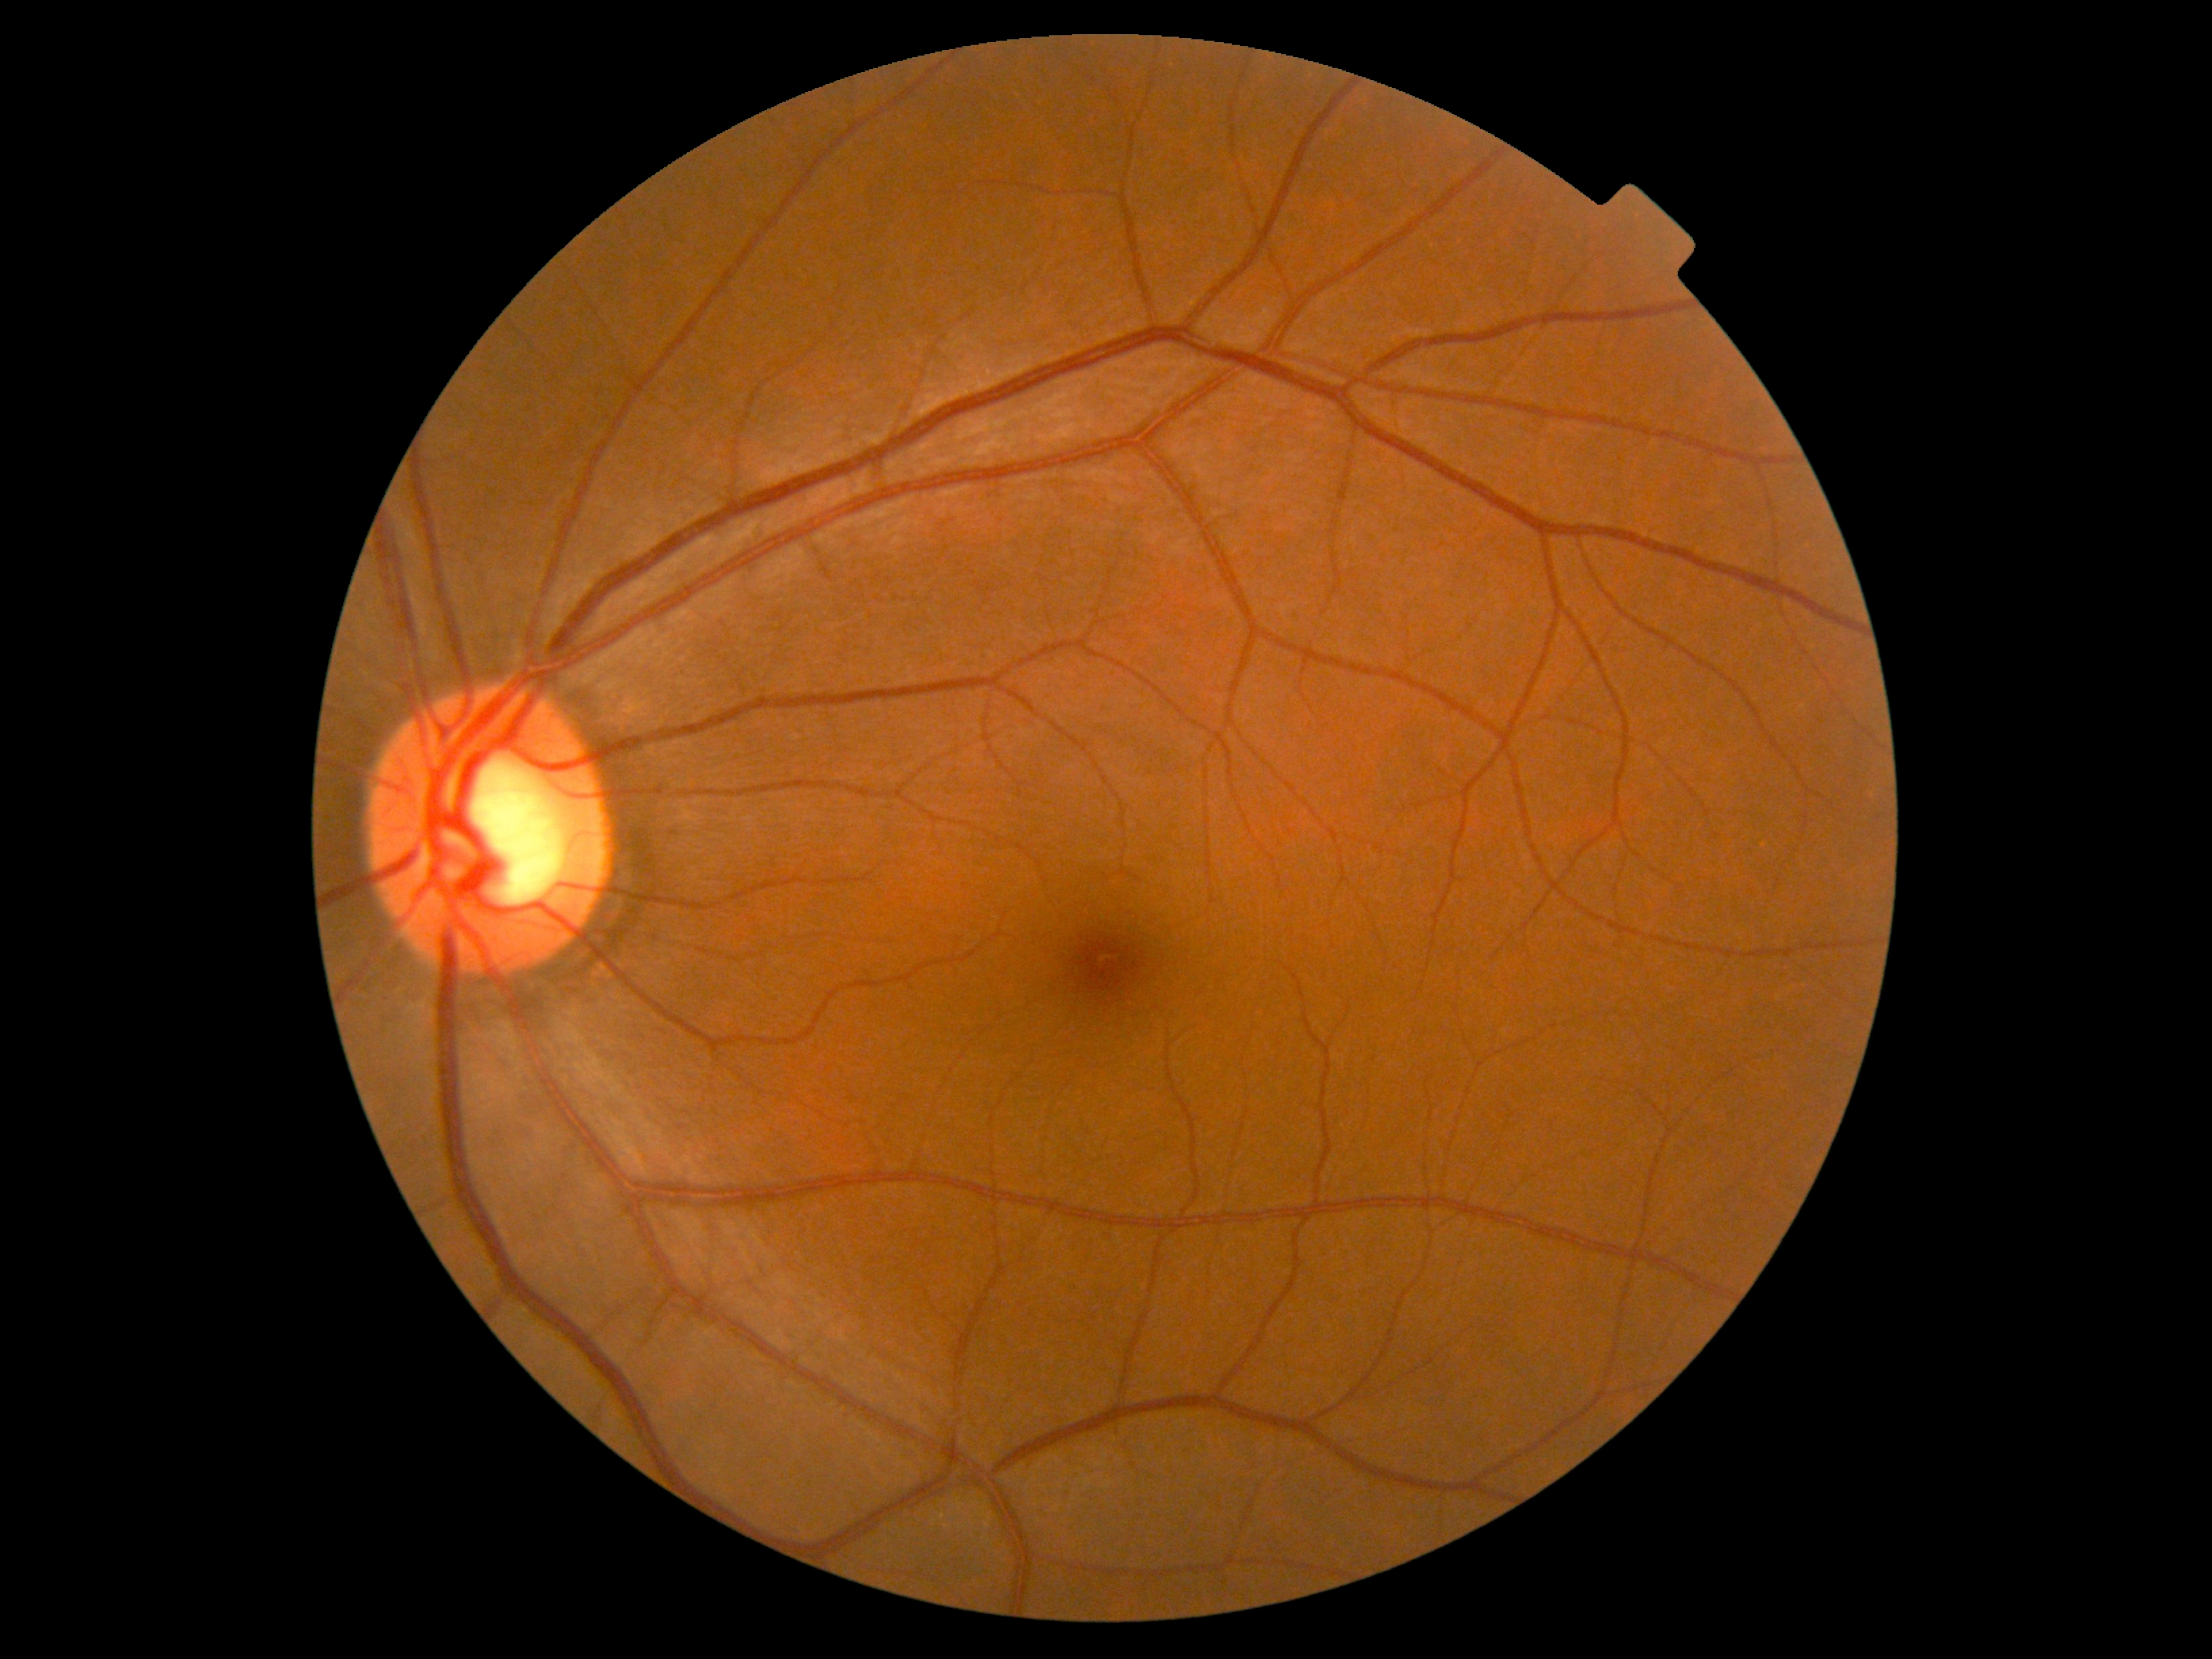
{"dr_grade": "0/4 — no visible signs of diabetic retinopathy"}